Modified Davis grading.
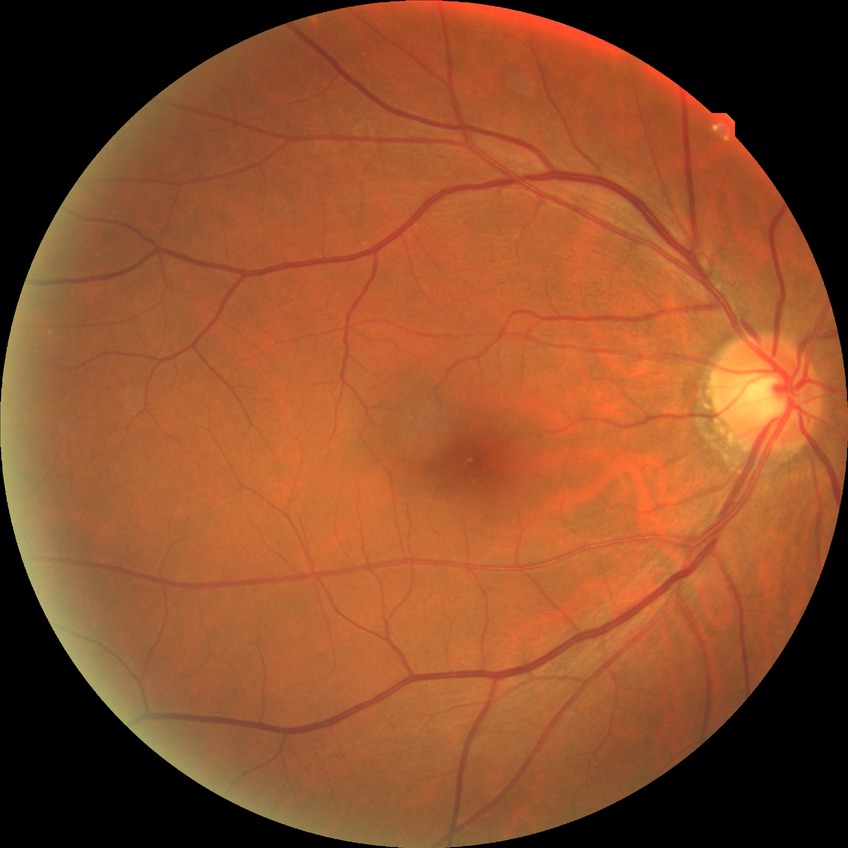 No DR findings. Davis DR grade is NDR.